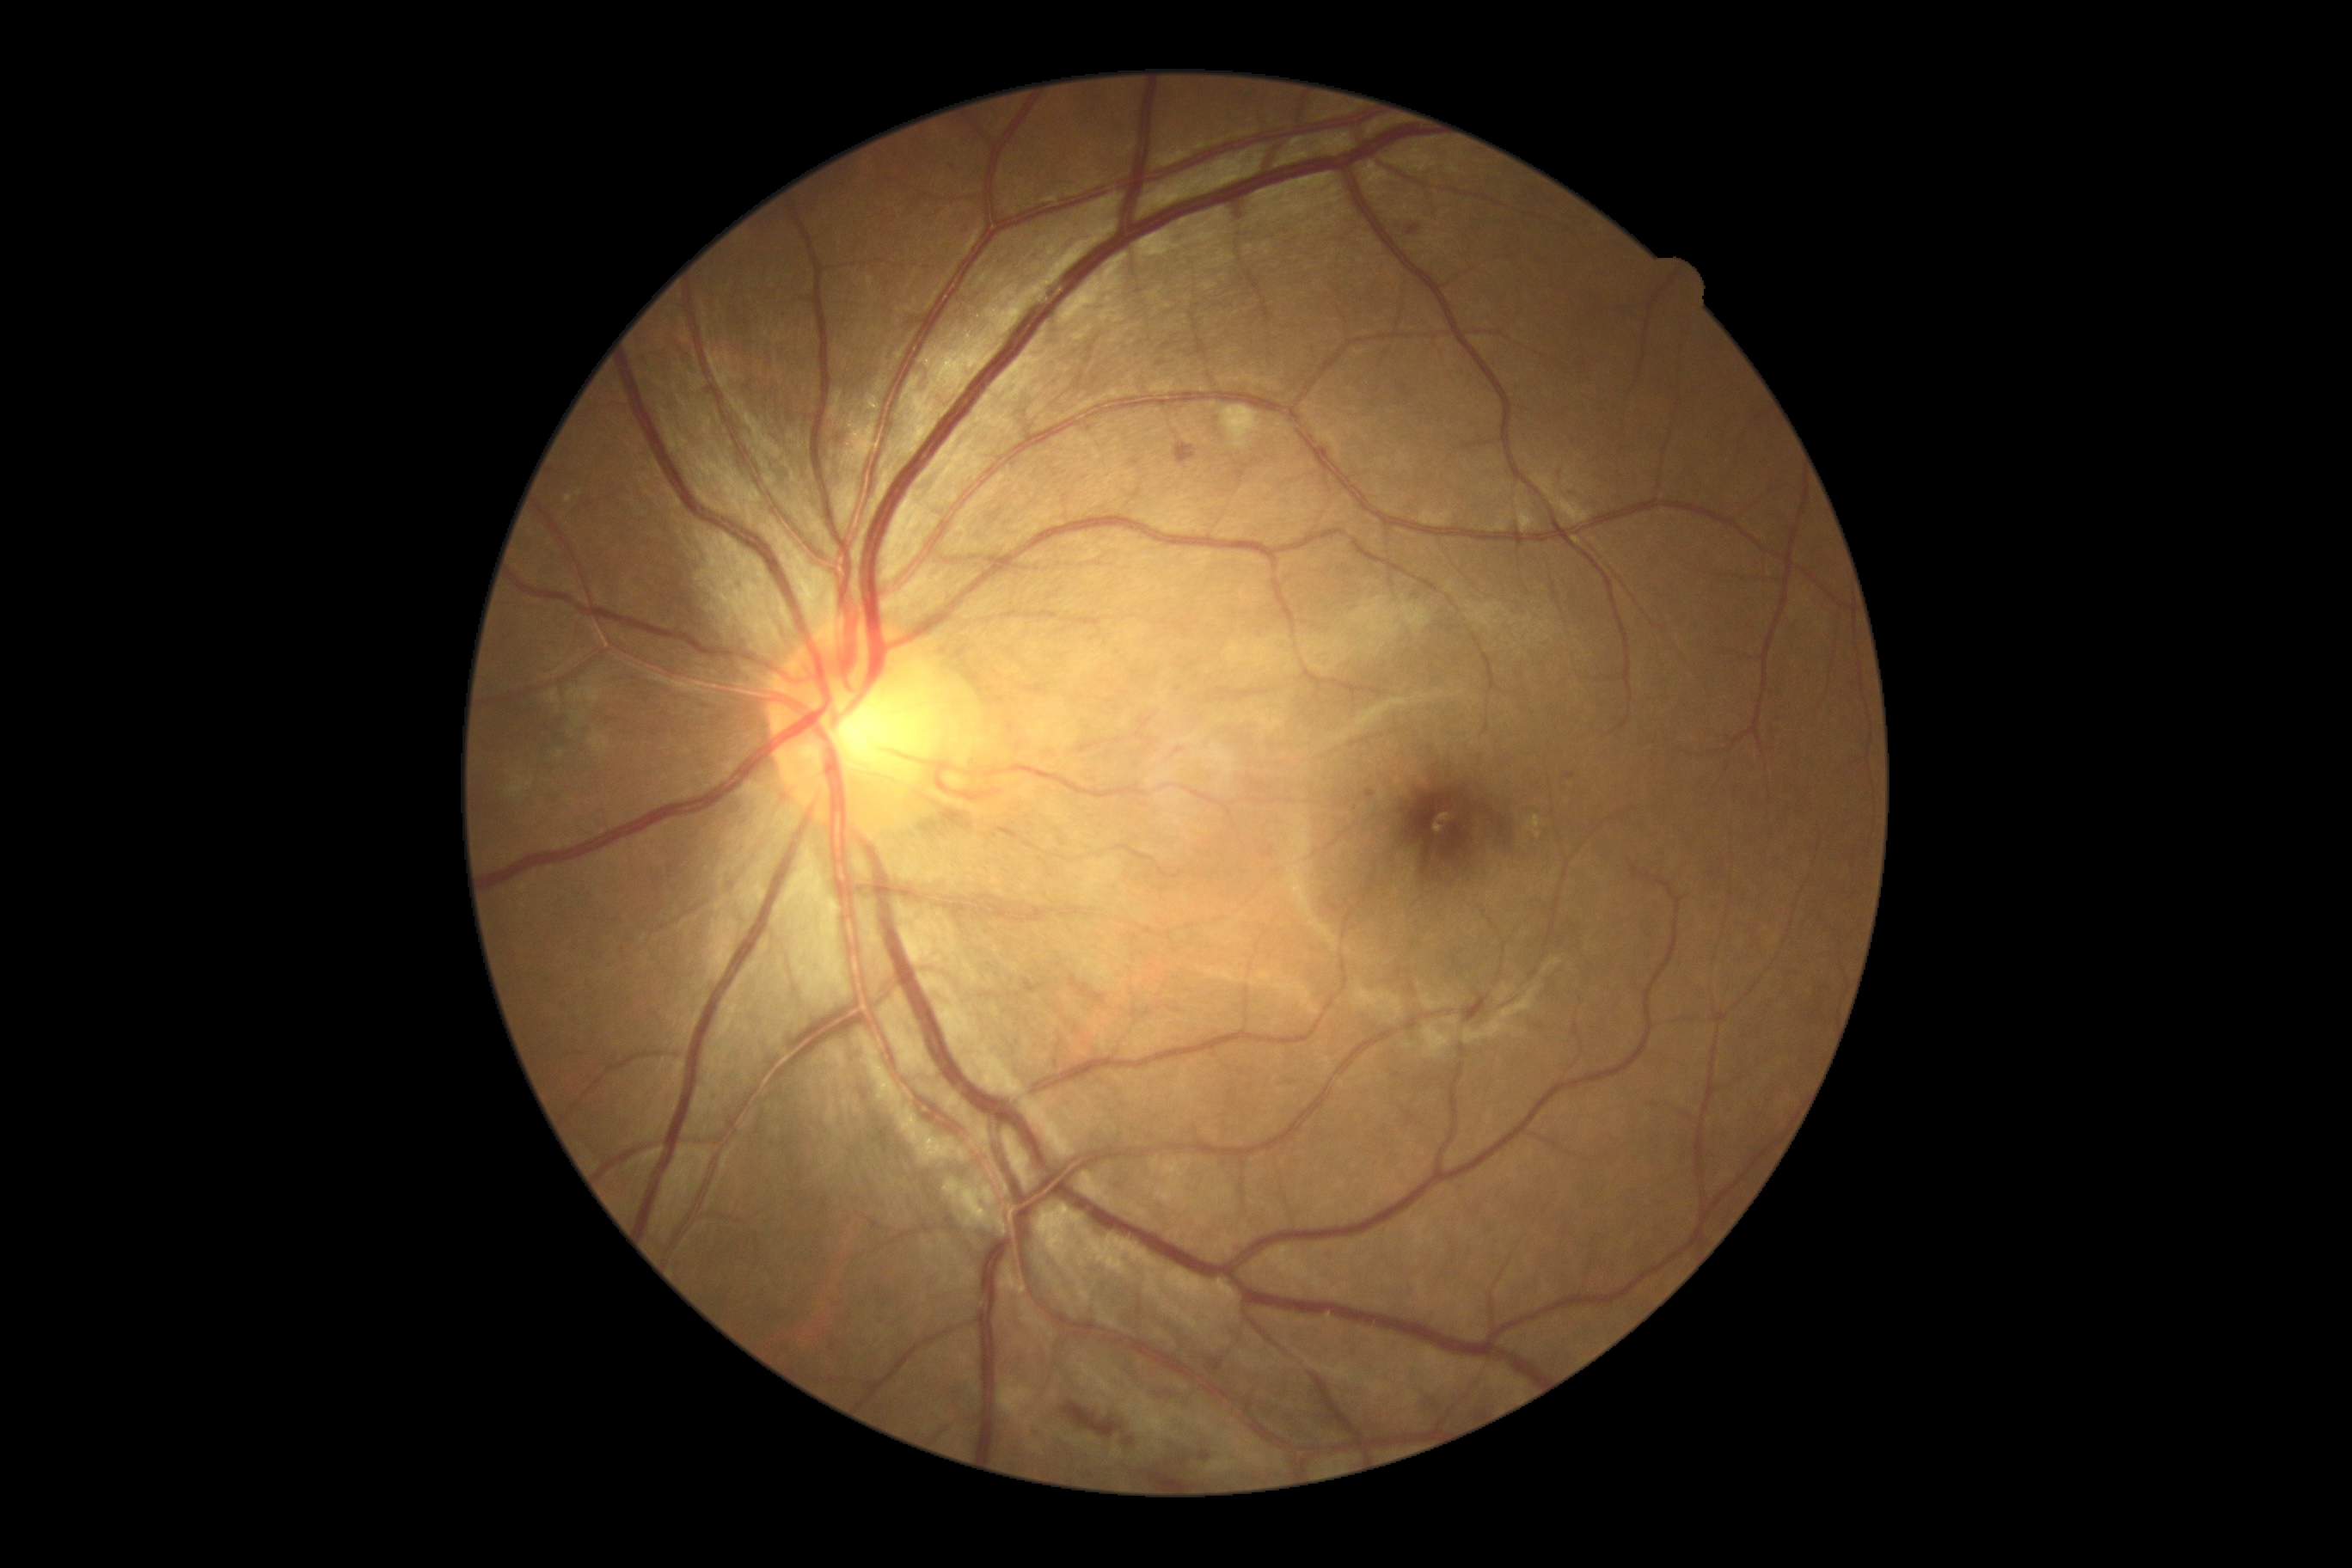 DR severity: moderate NPDR (grade 2).